45 degree fundus photograph, CFP, without pupil dilation, 848x848: 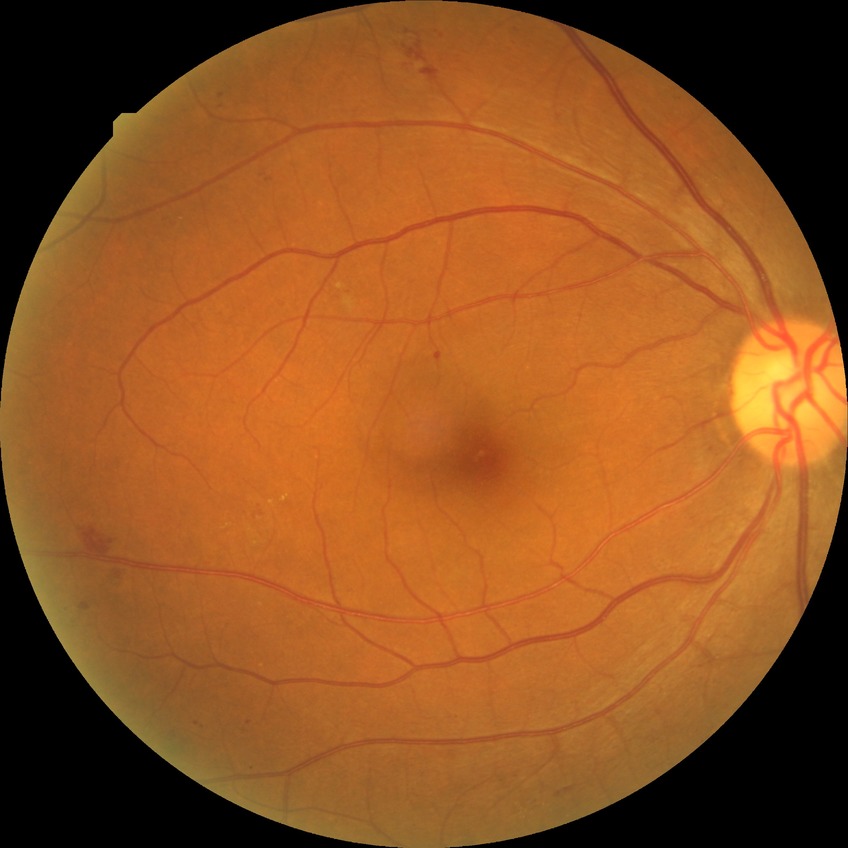 Diabetic retinopathy (DR) is pre-proliferative diabetic retinopathy (PPDR).